Fundus photo — 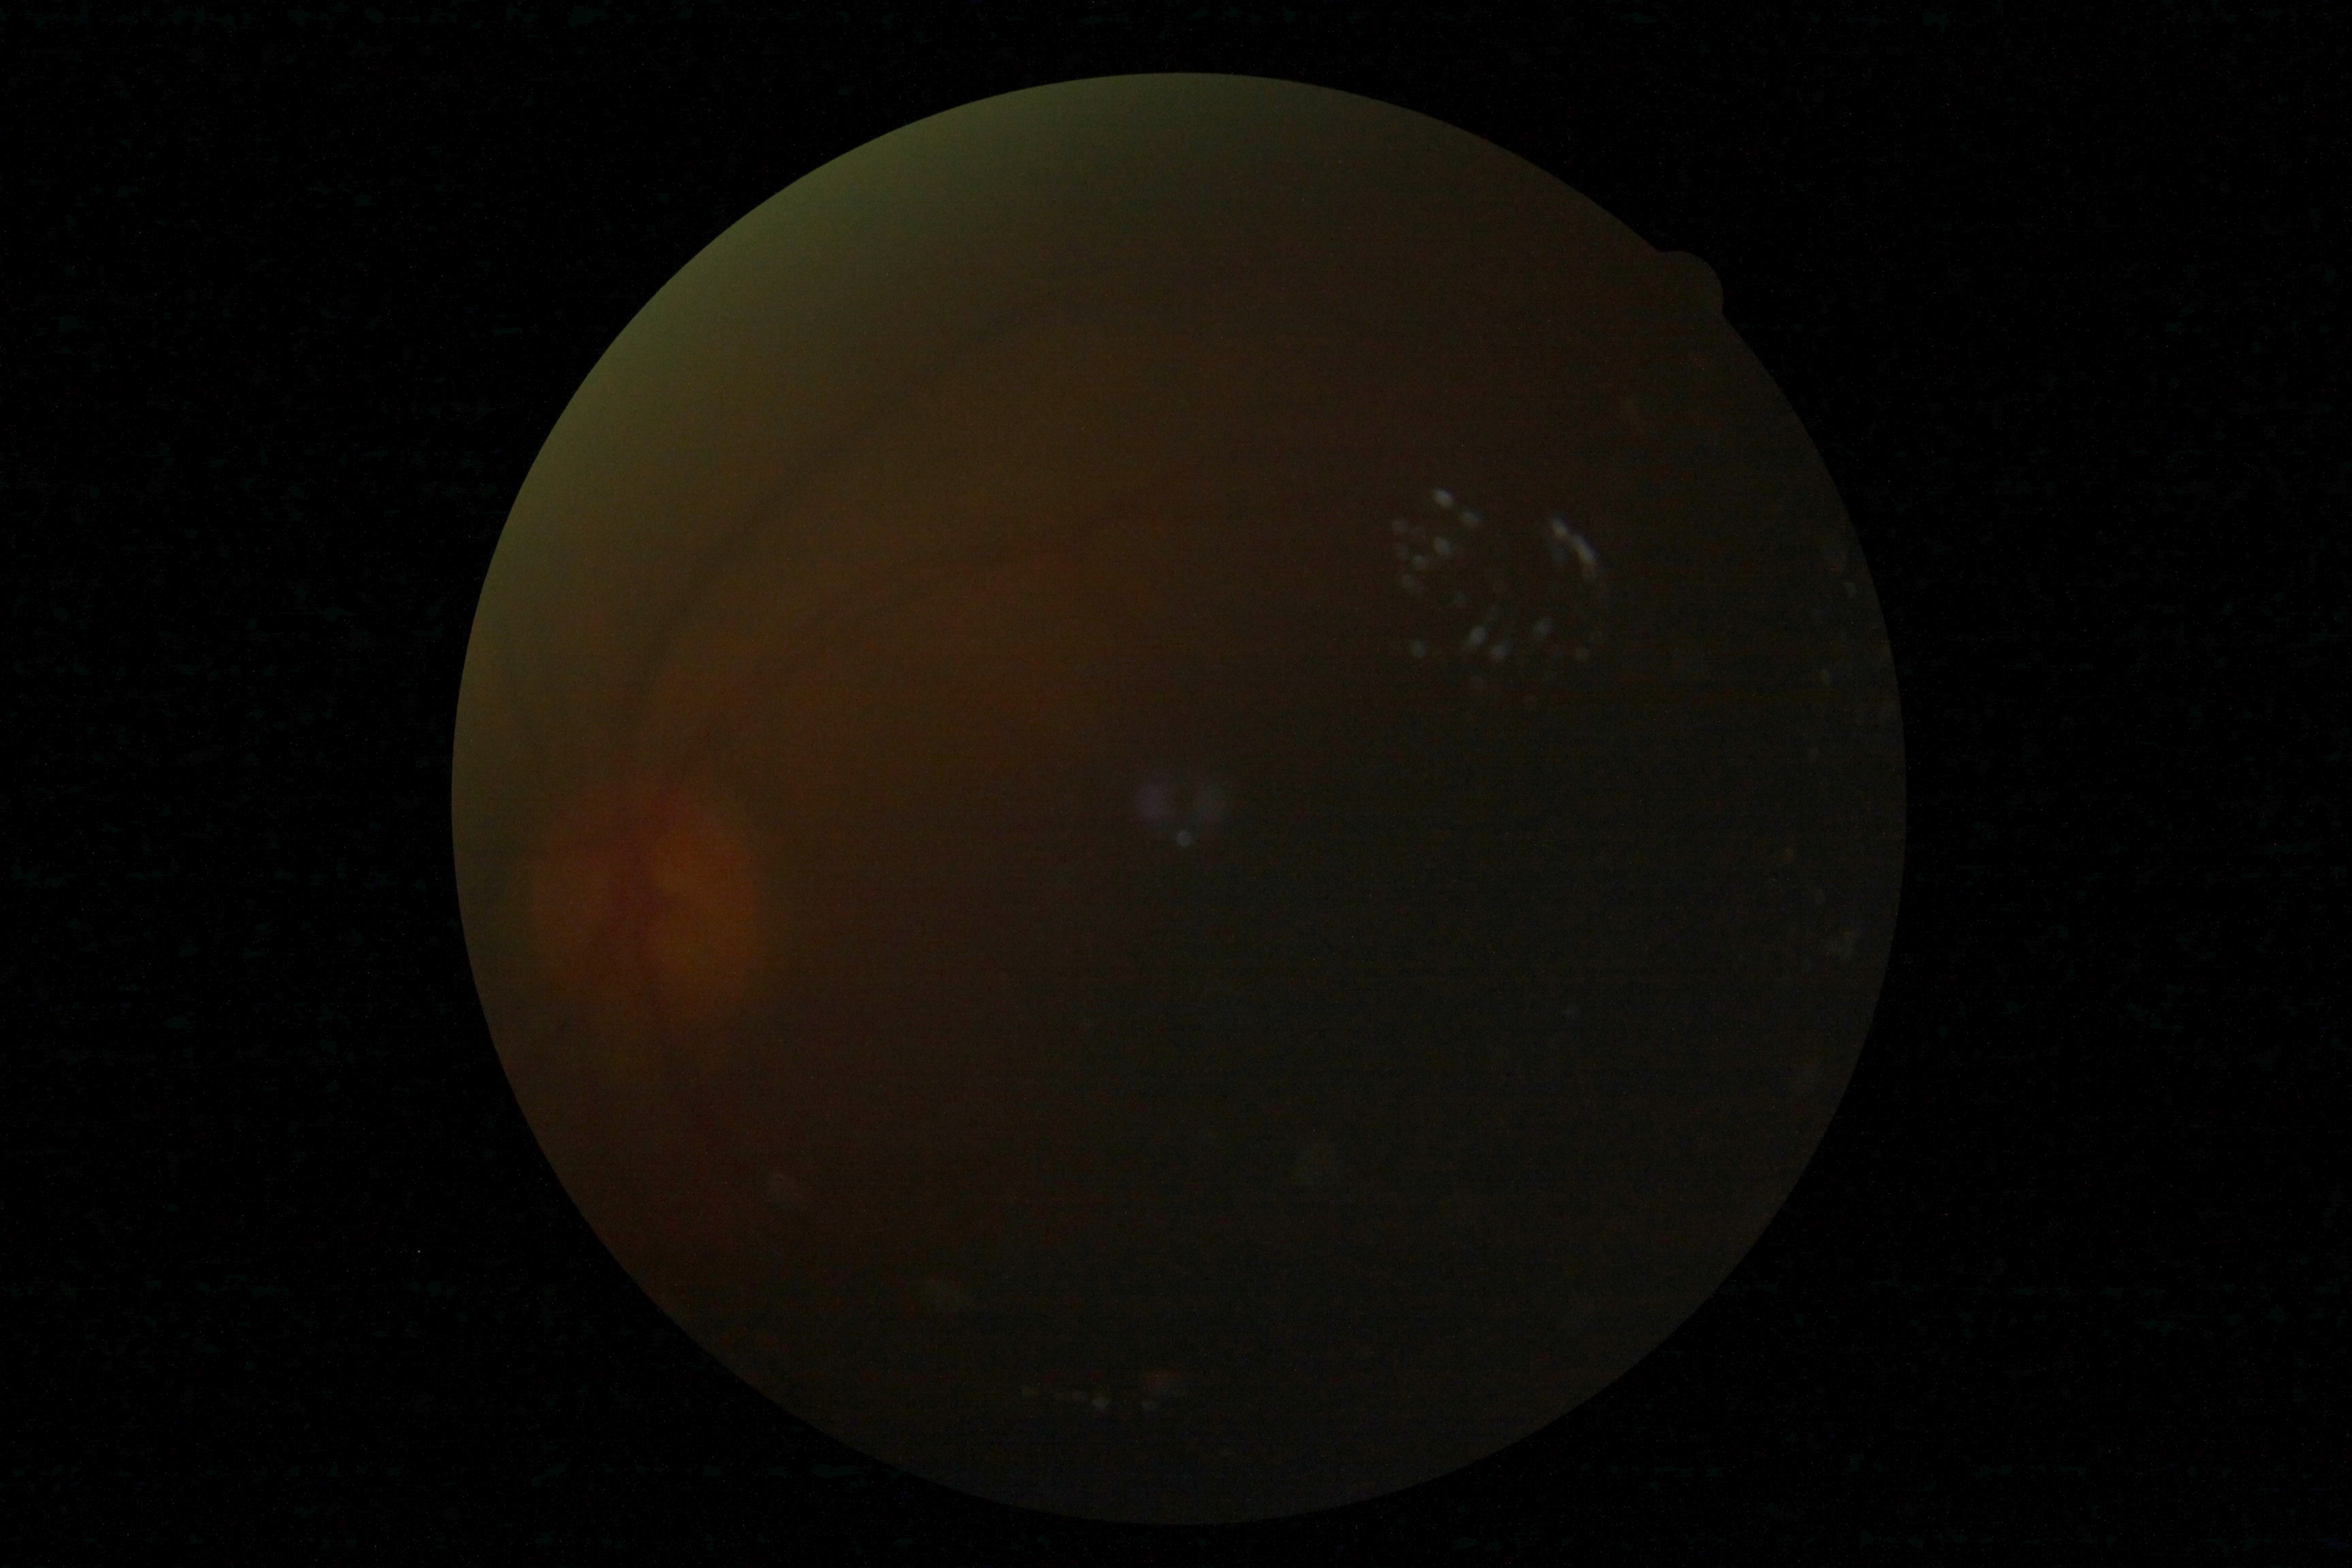 DR severity: ungradable.